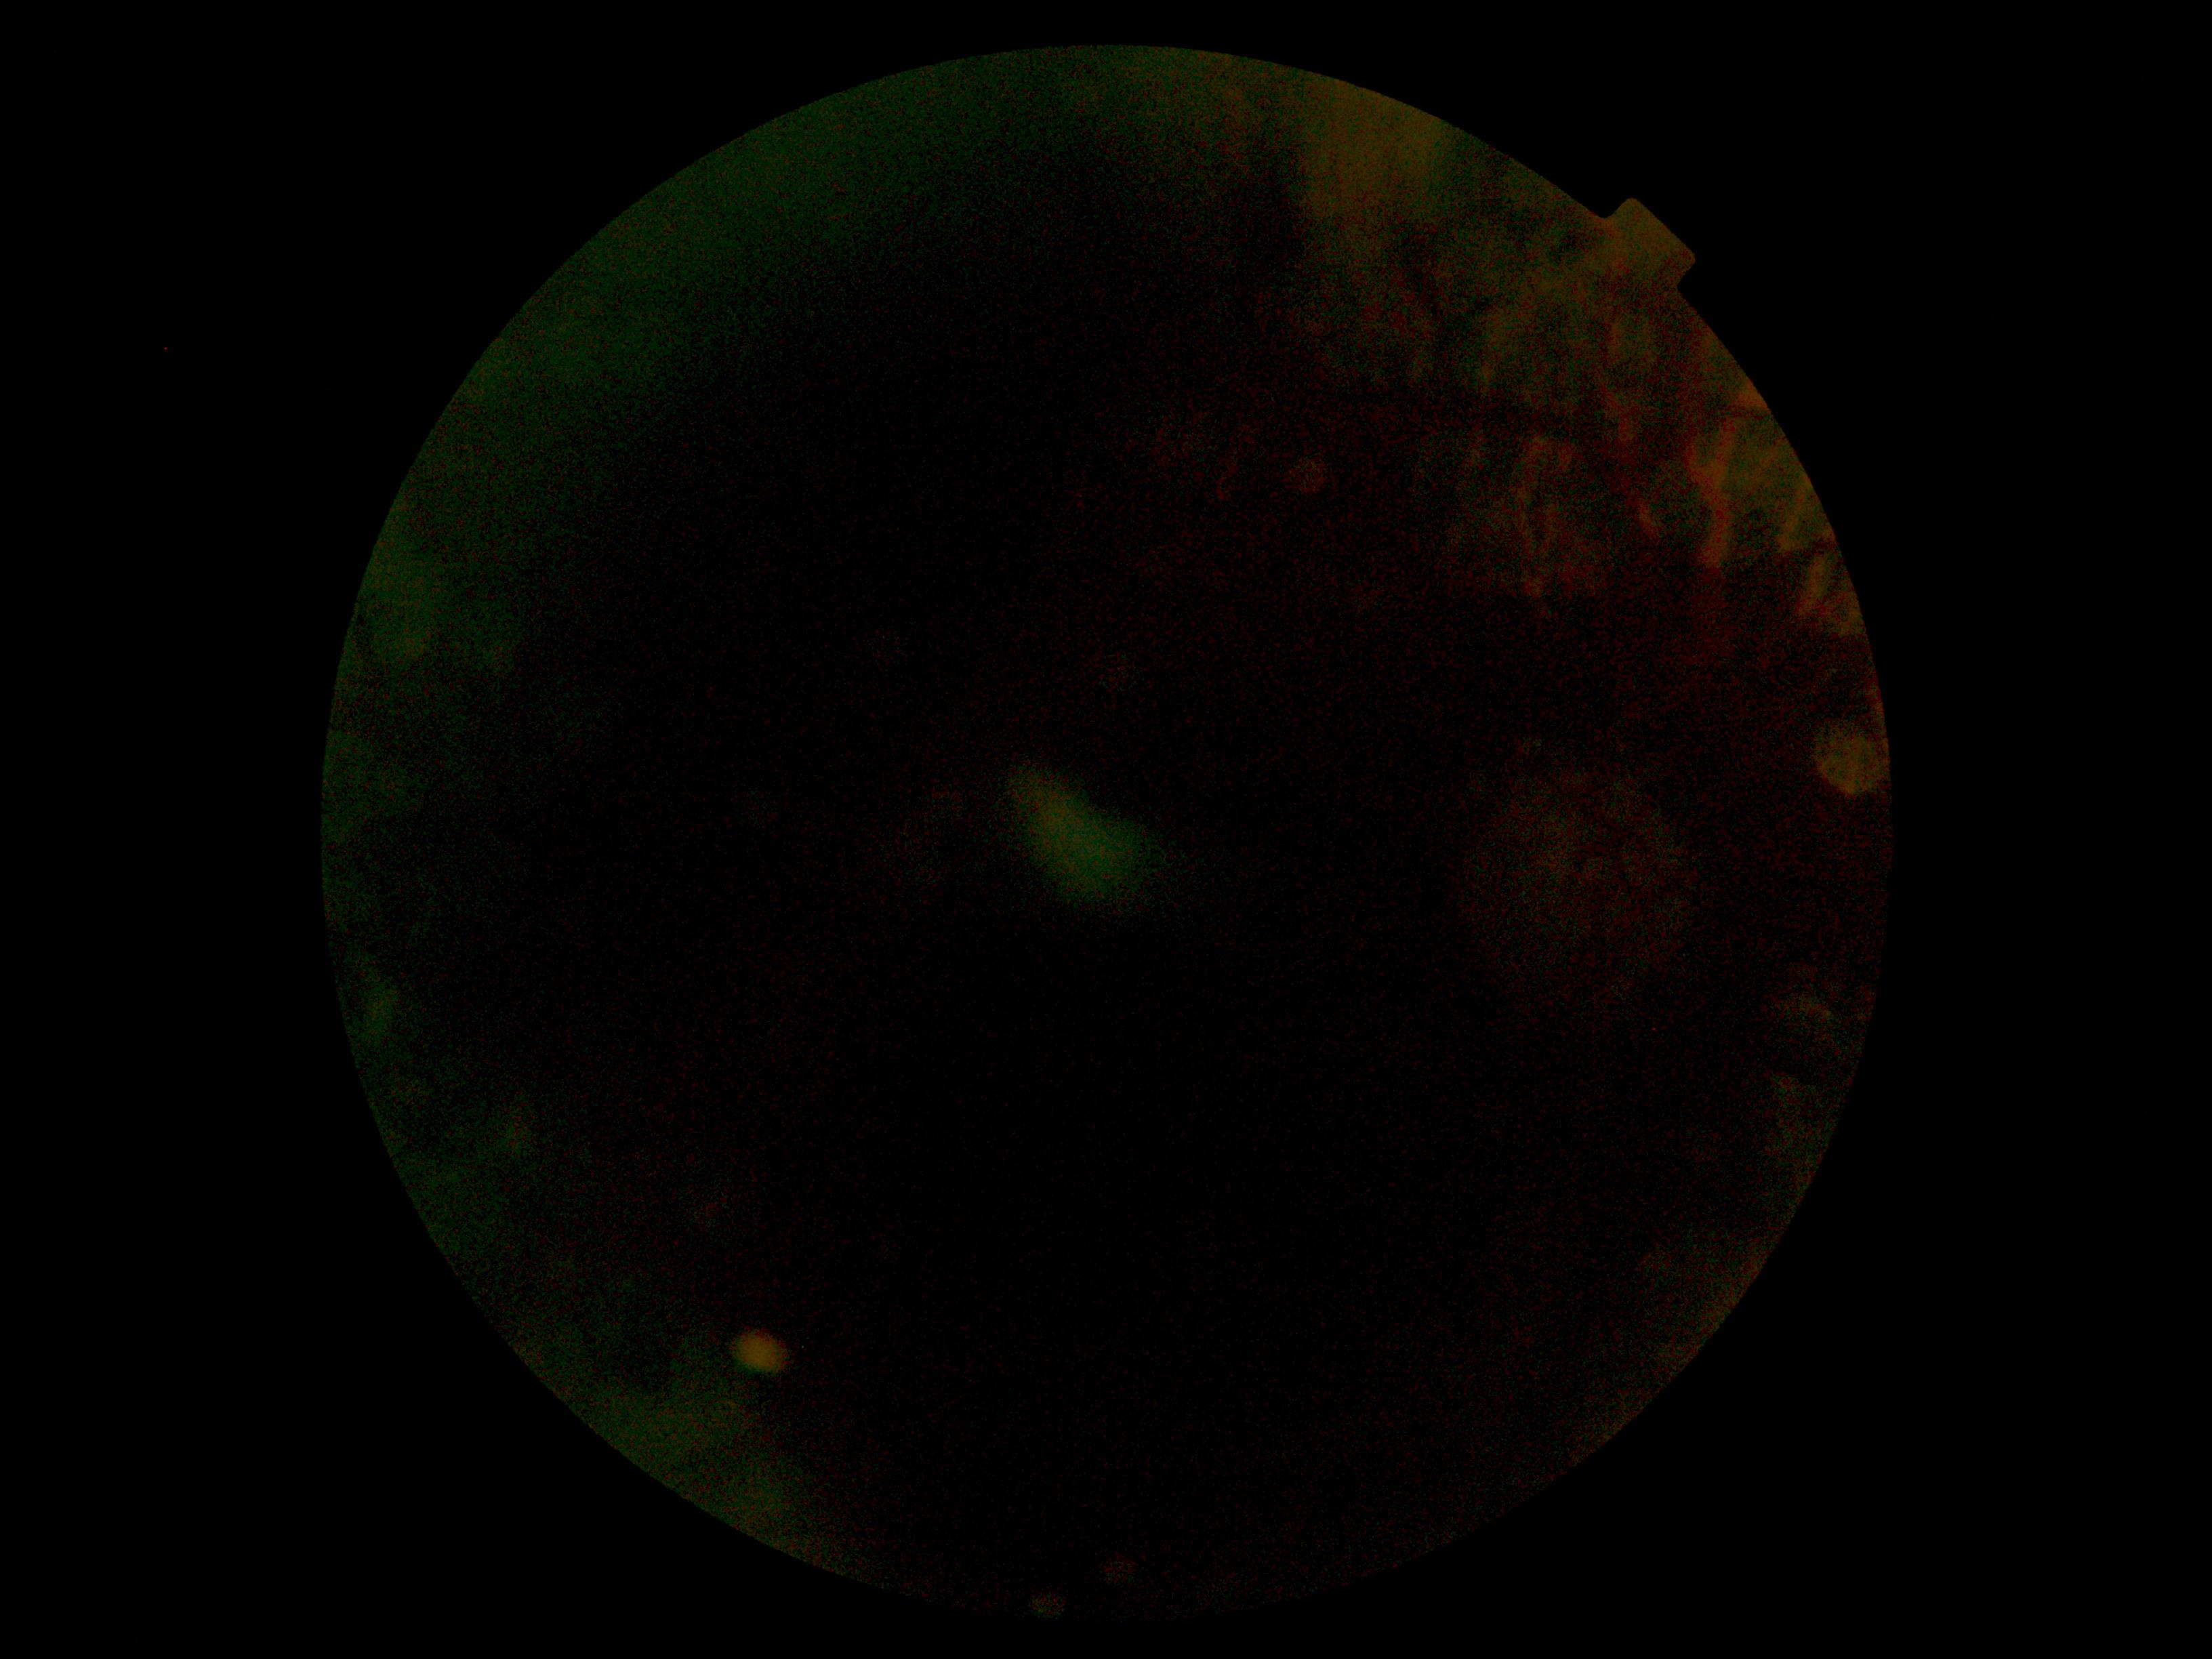
DR grade is ungradable. Image quality is insufficient for diabetic retinopathy assessment.